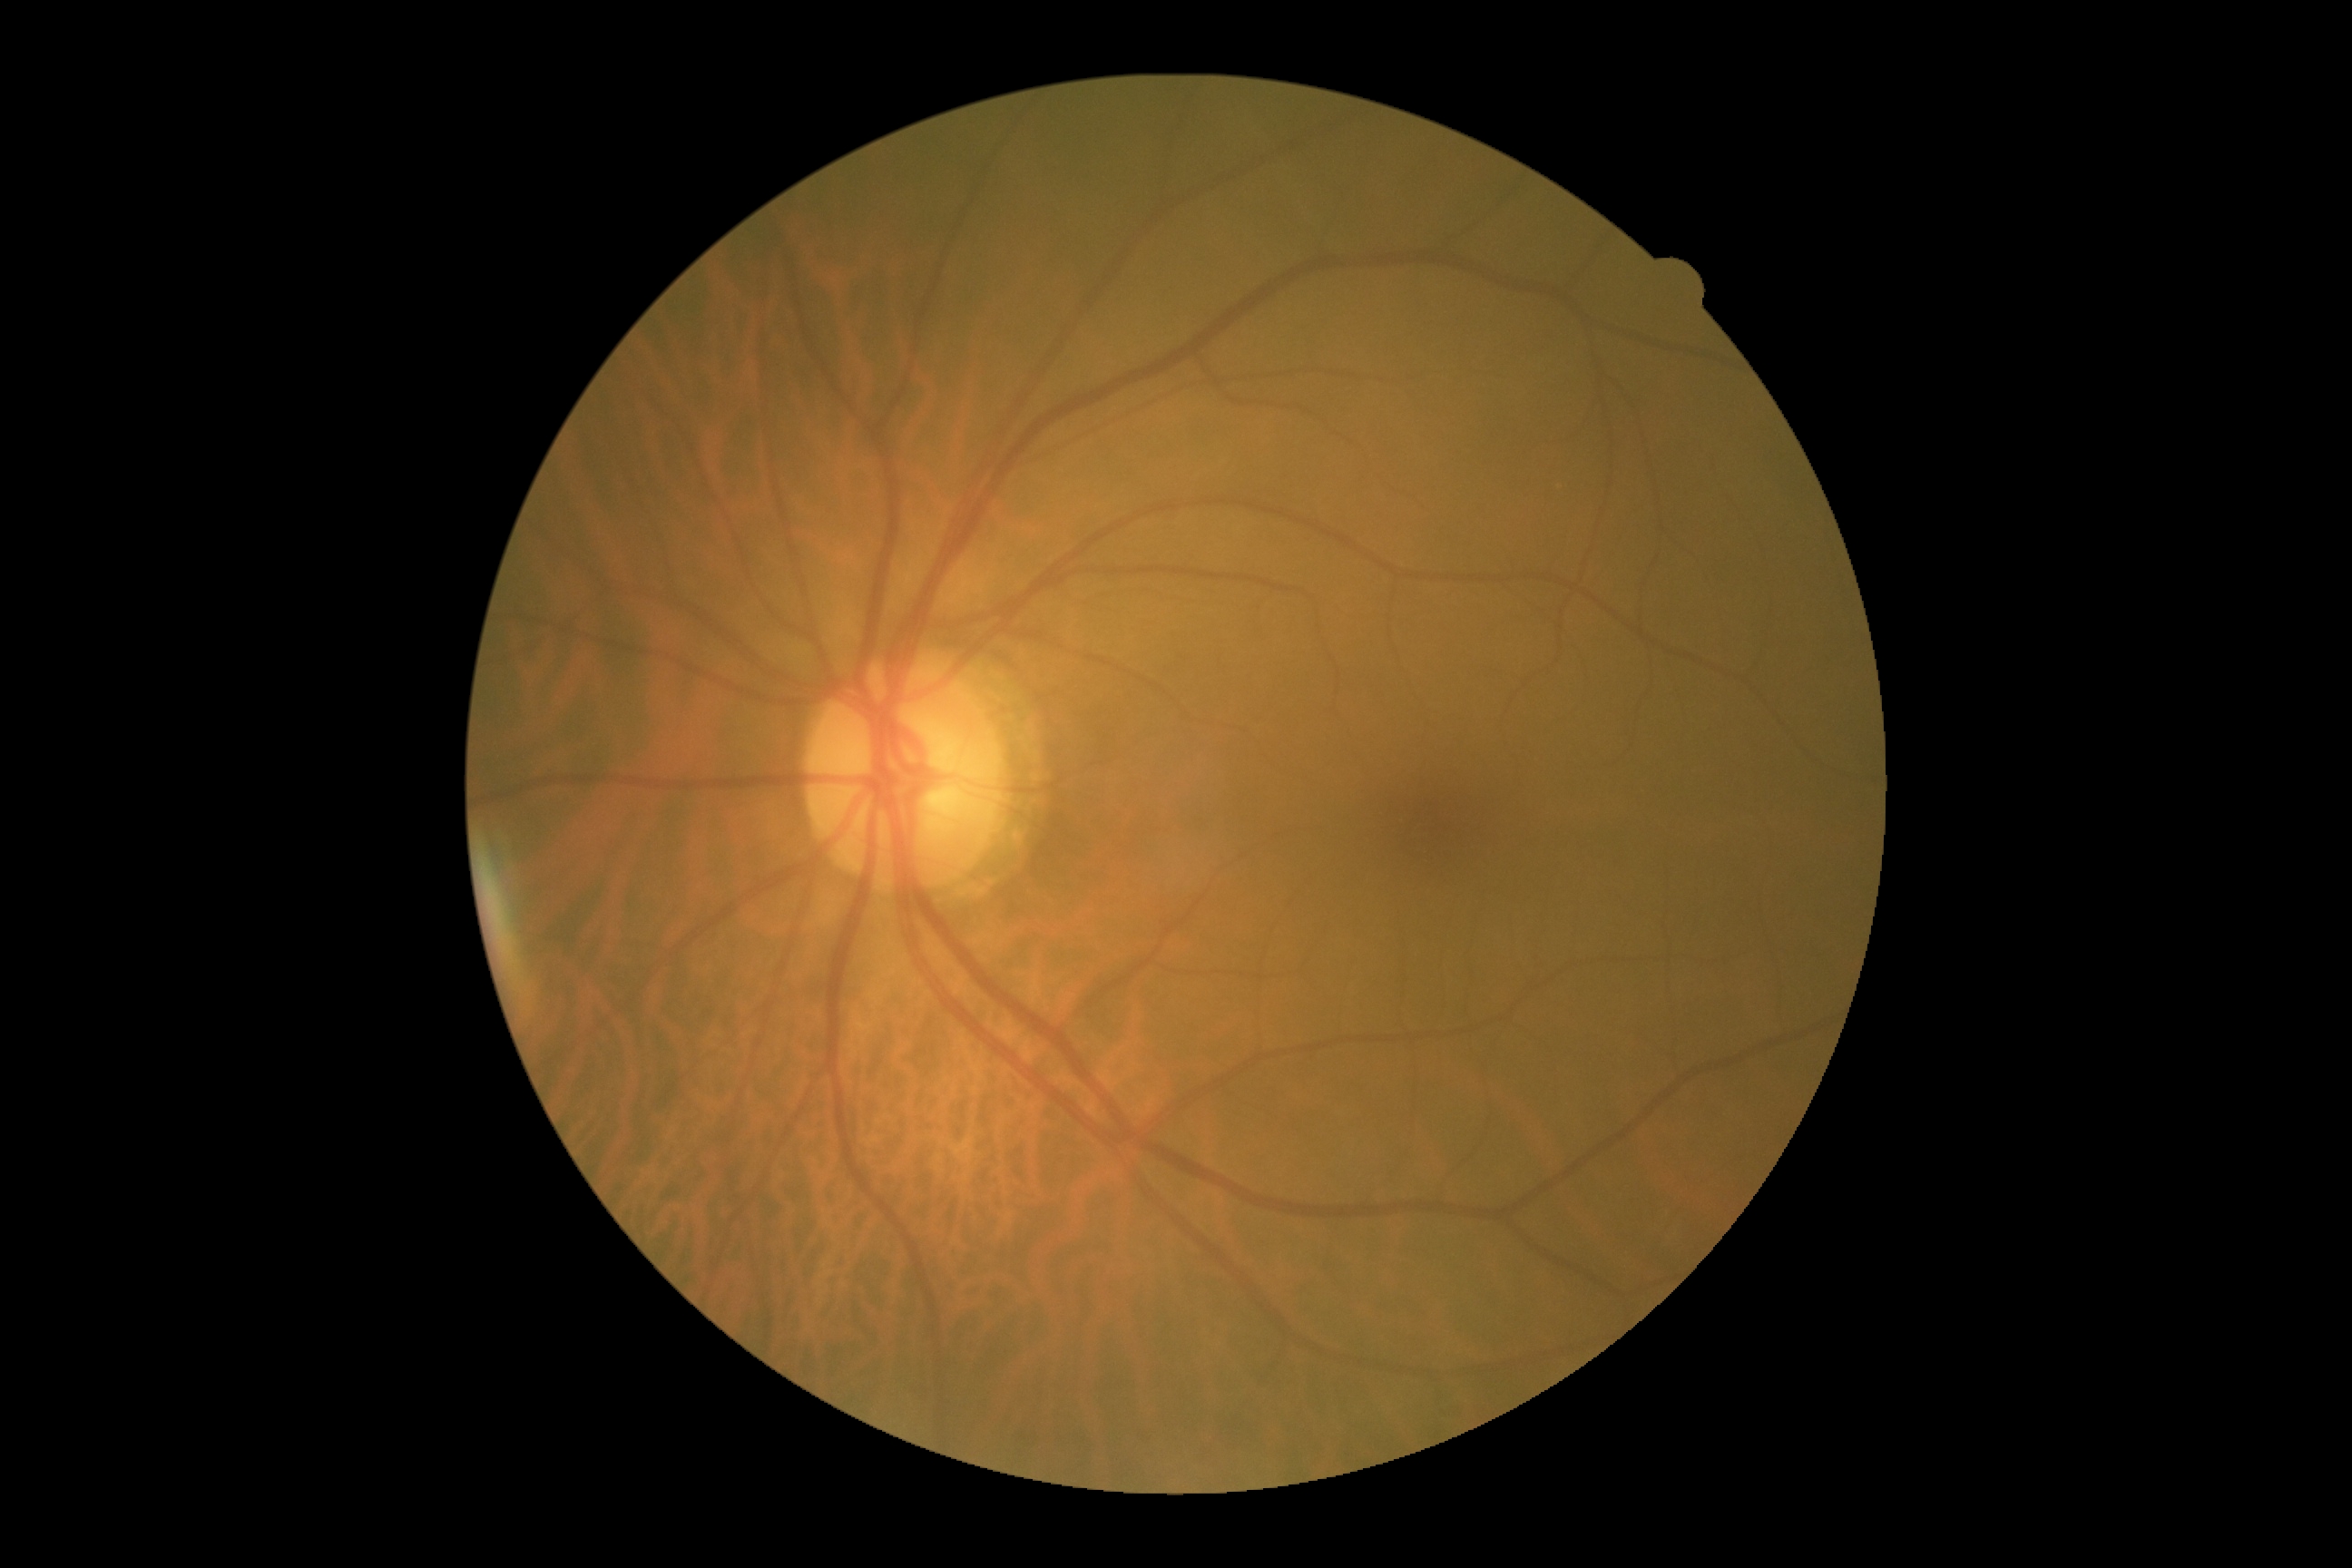

• diabetic retinopathy: grade 0